Acquired with a NIDEK AFC-230 · posterior pole photograph:
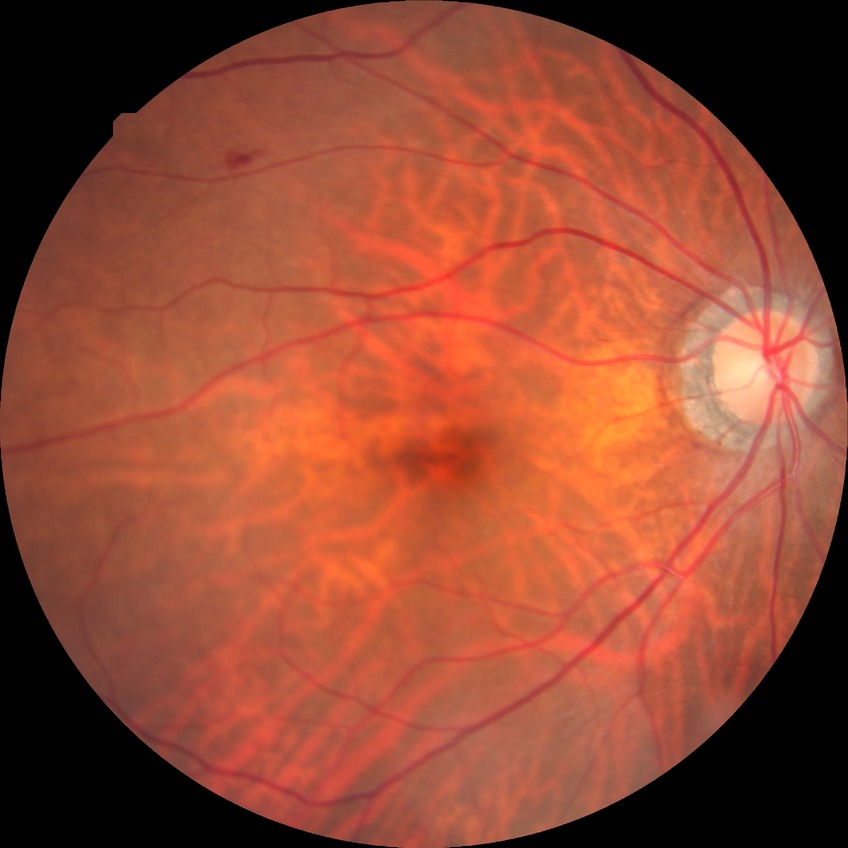

davis_grade: SDR (simple diabetic retinopathy)